Acquired with a NIDEK AFC-230; CFP; 848x848; Davis DR grading:
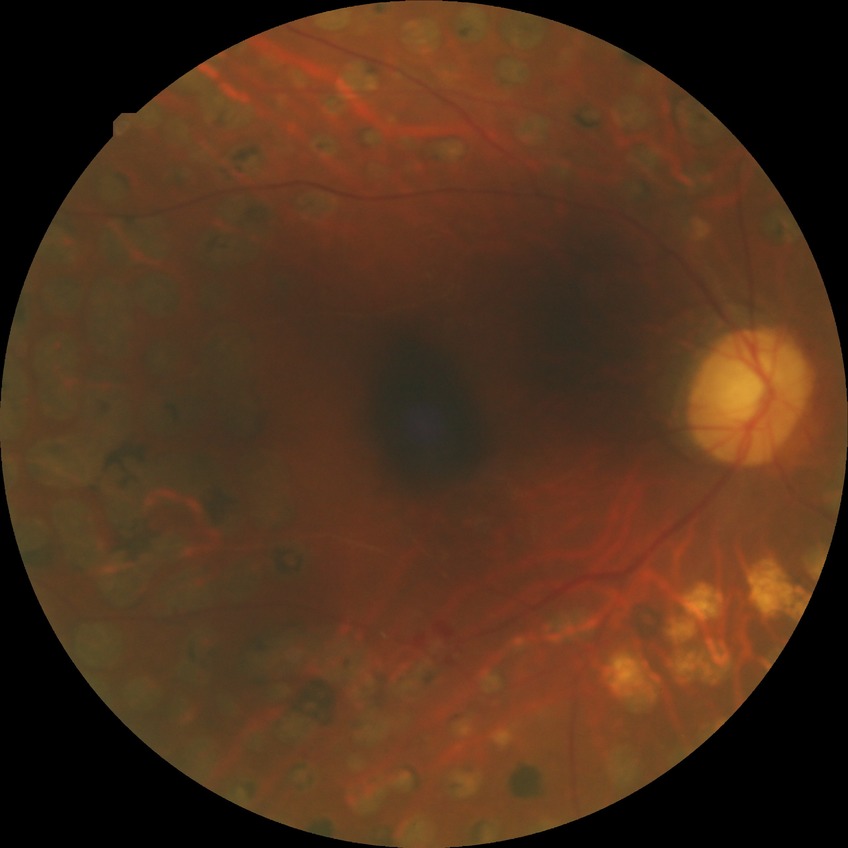
Diabetic retinopathy (DR): PDR (proliferative diabetic retinopathy).